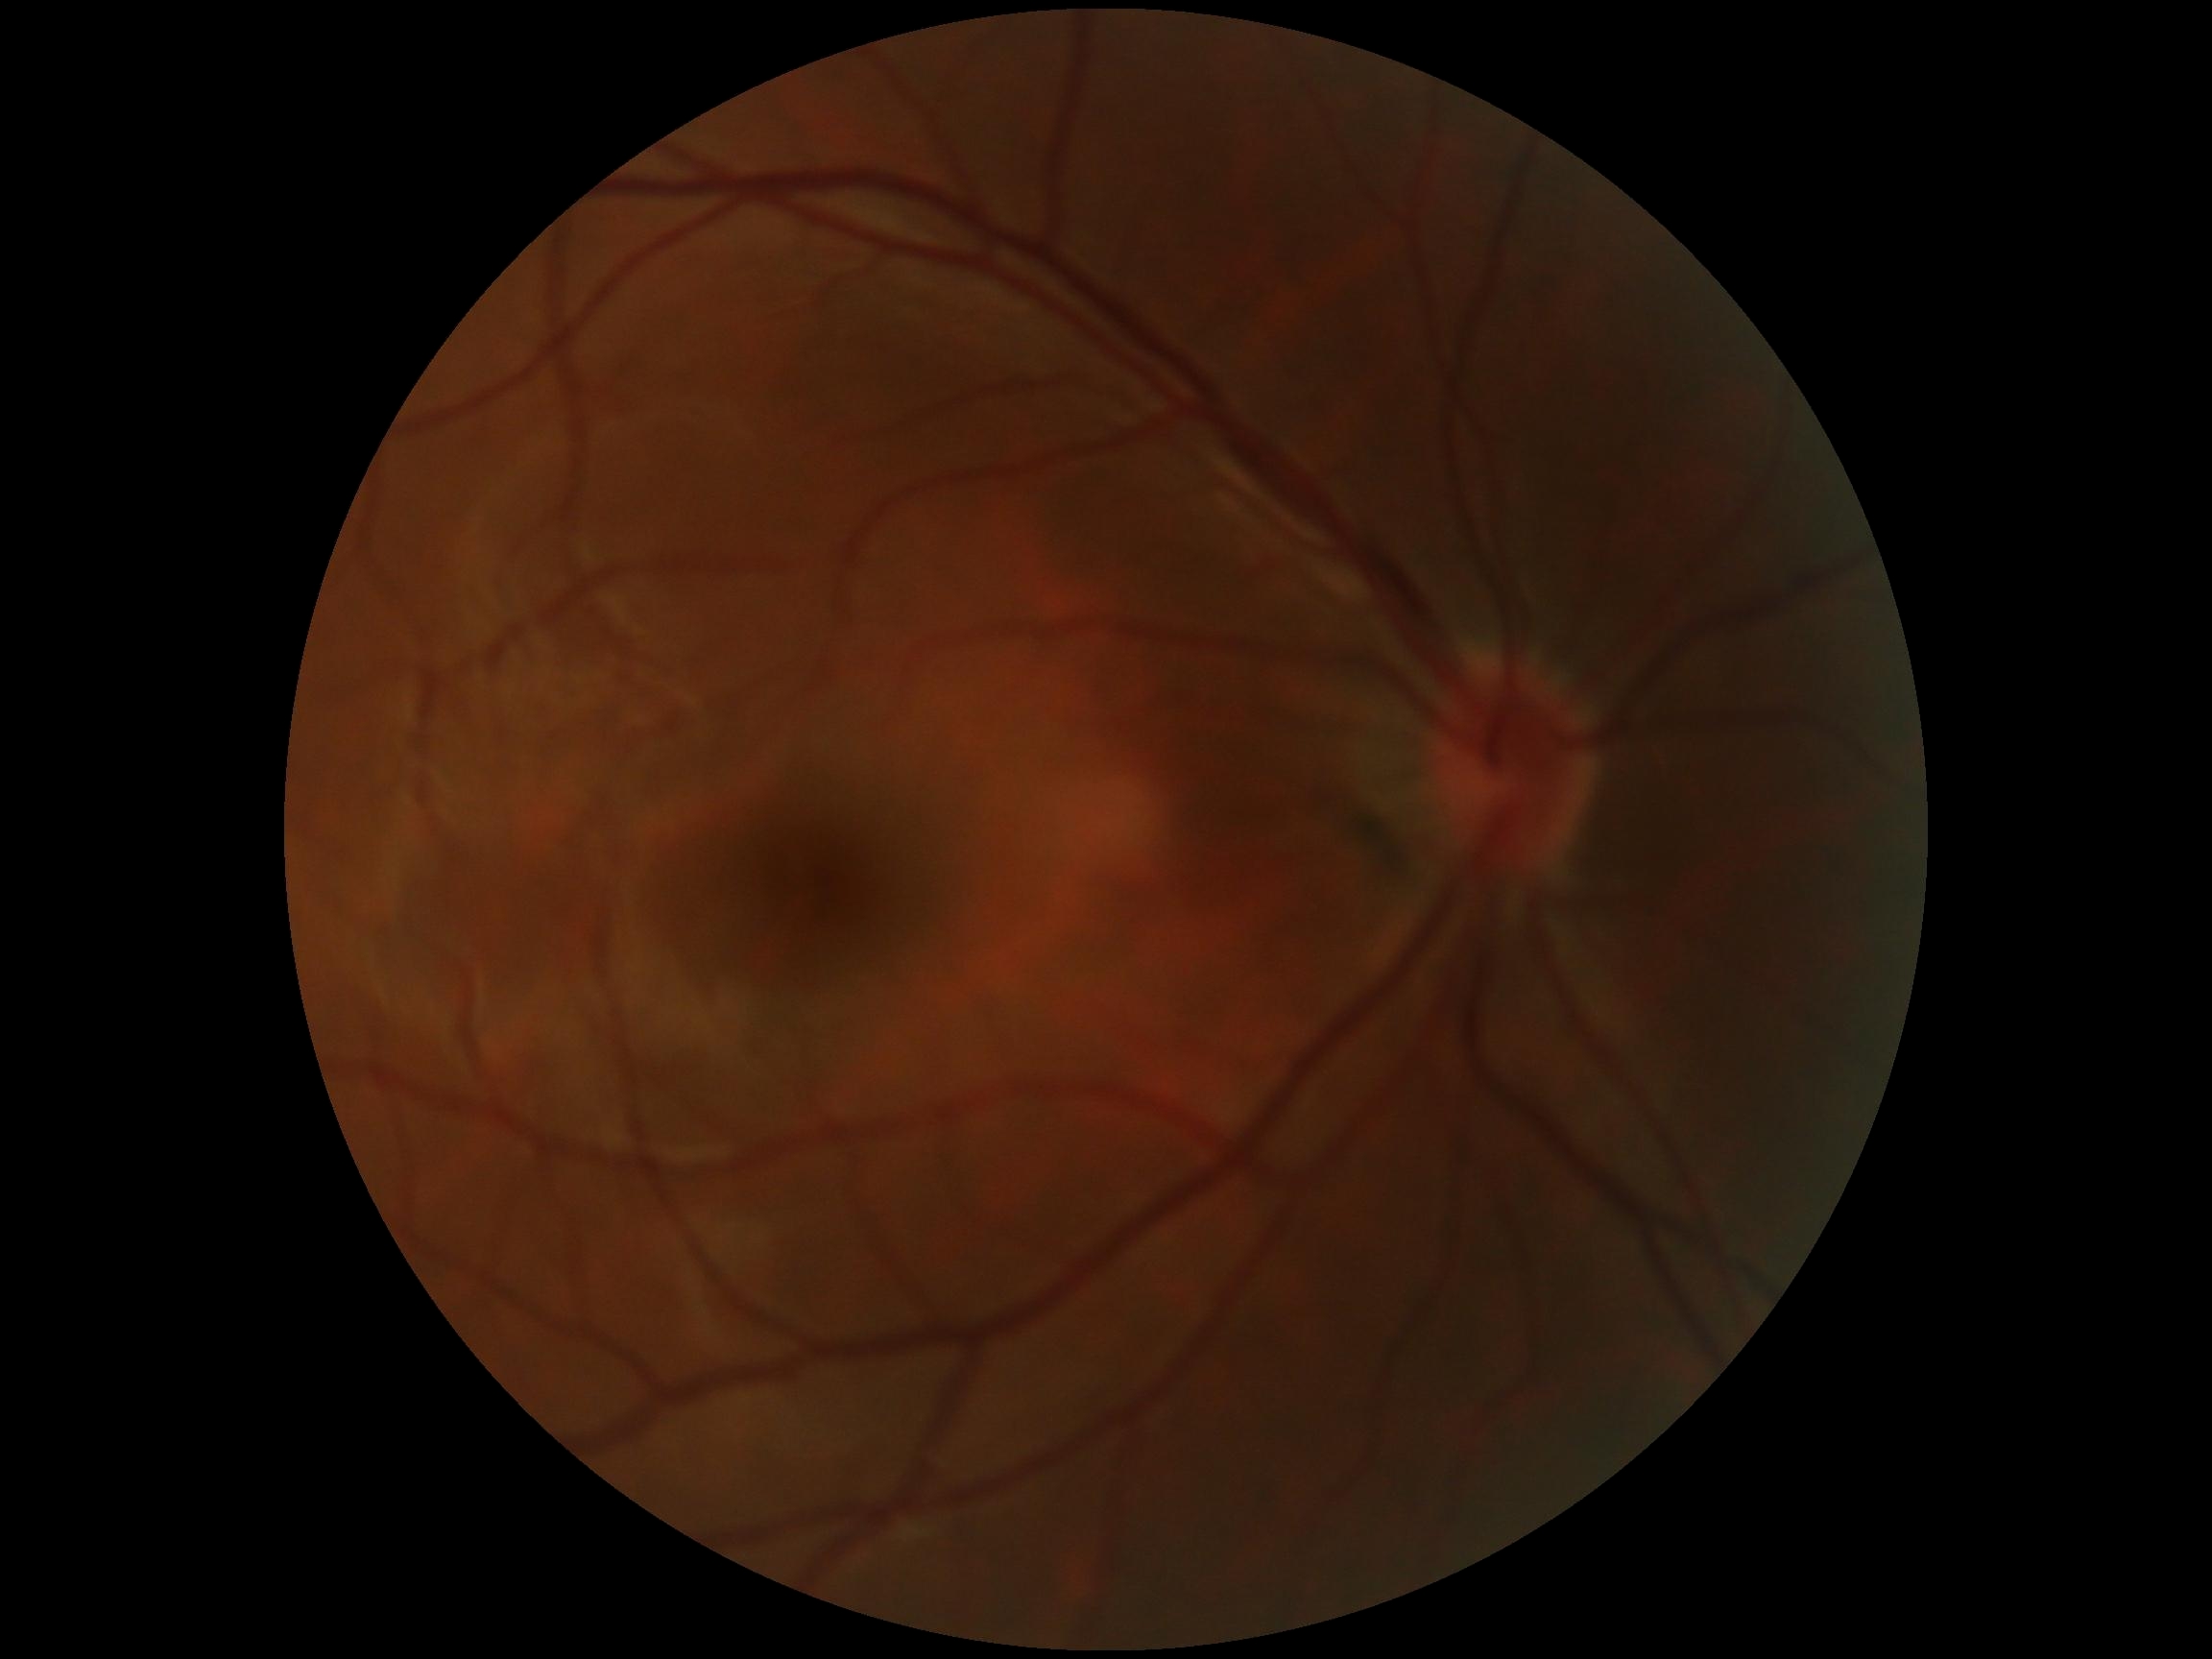
{"dr_grade": "no apparent diabetic retinopathy (grade 0)"}